1659 x 2212 pixels:
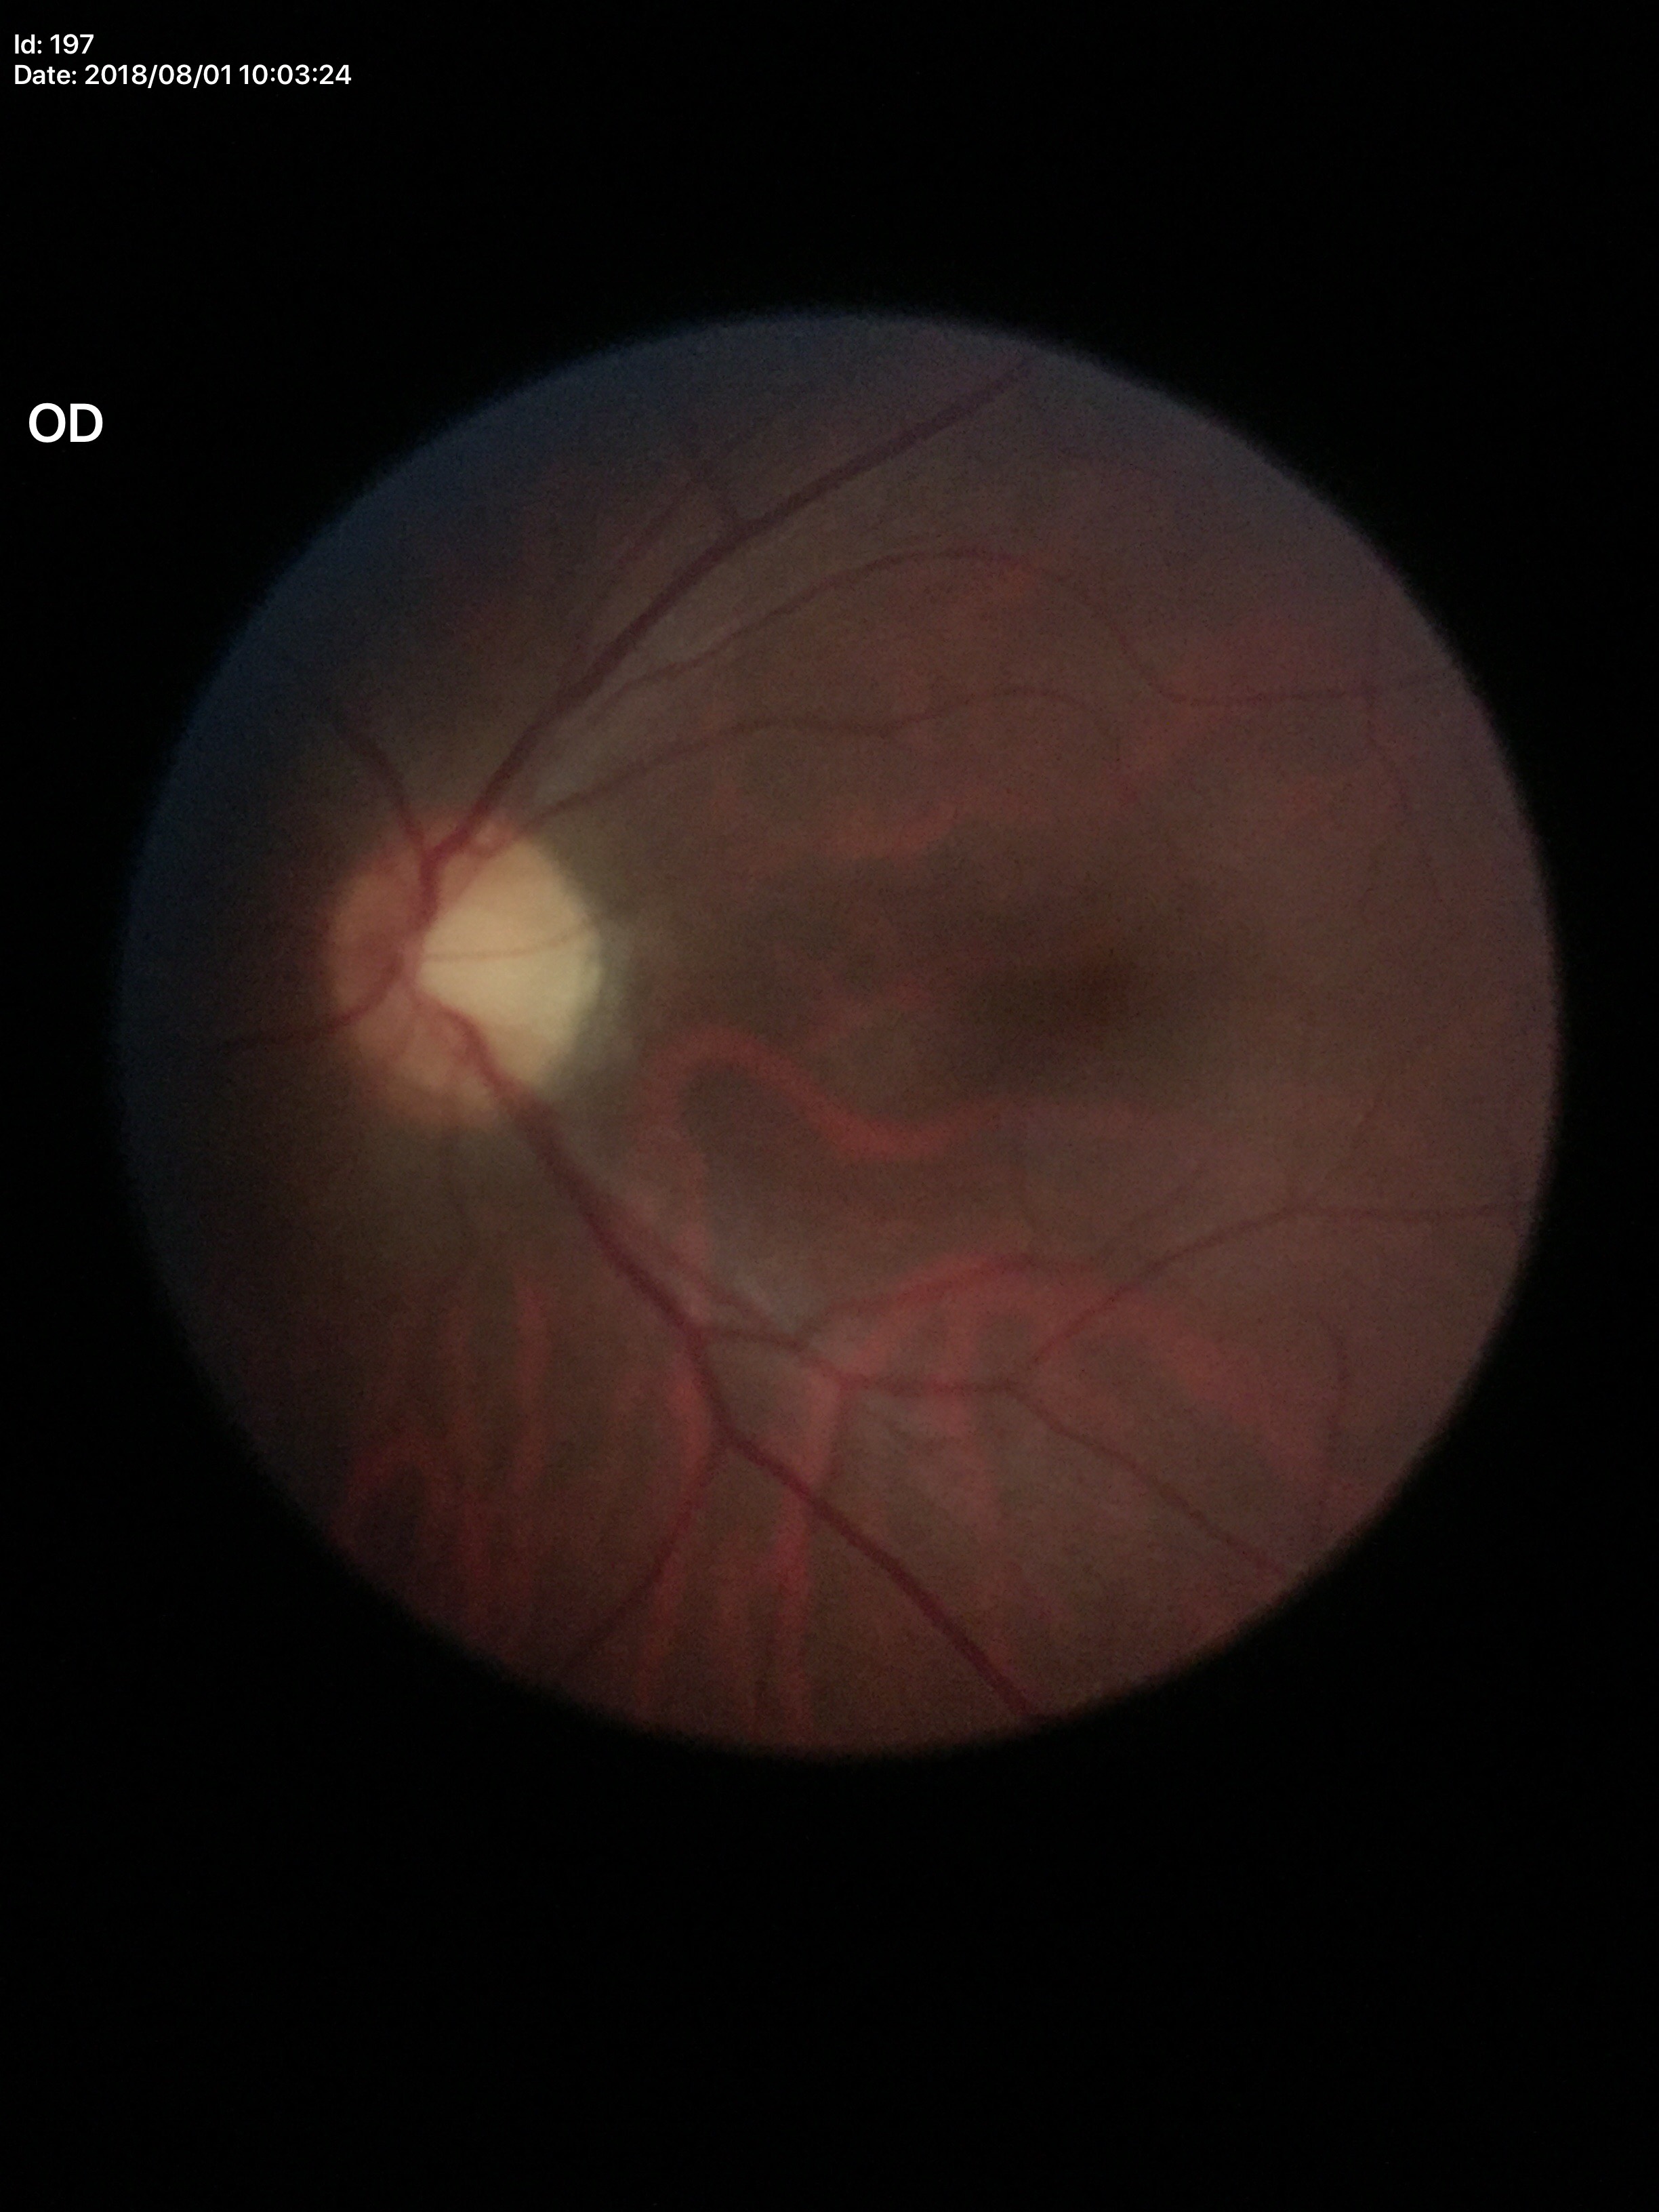 {
  "vcdr": "0.52",
  "glaucoma_decision": "negative",
  "acdr": "0.29"
}